45° field of view; 2352 x 1568 pixels; color fundus image — 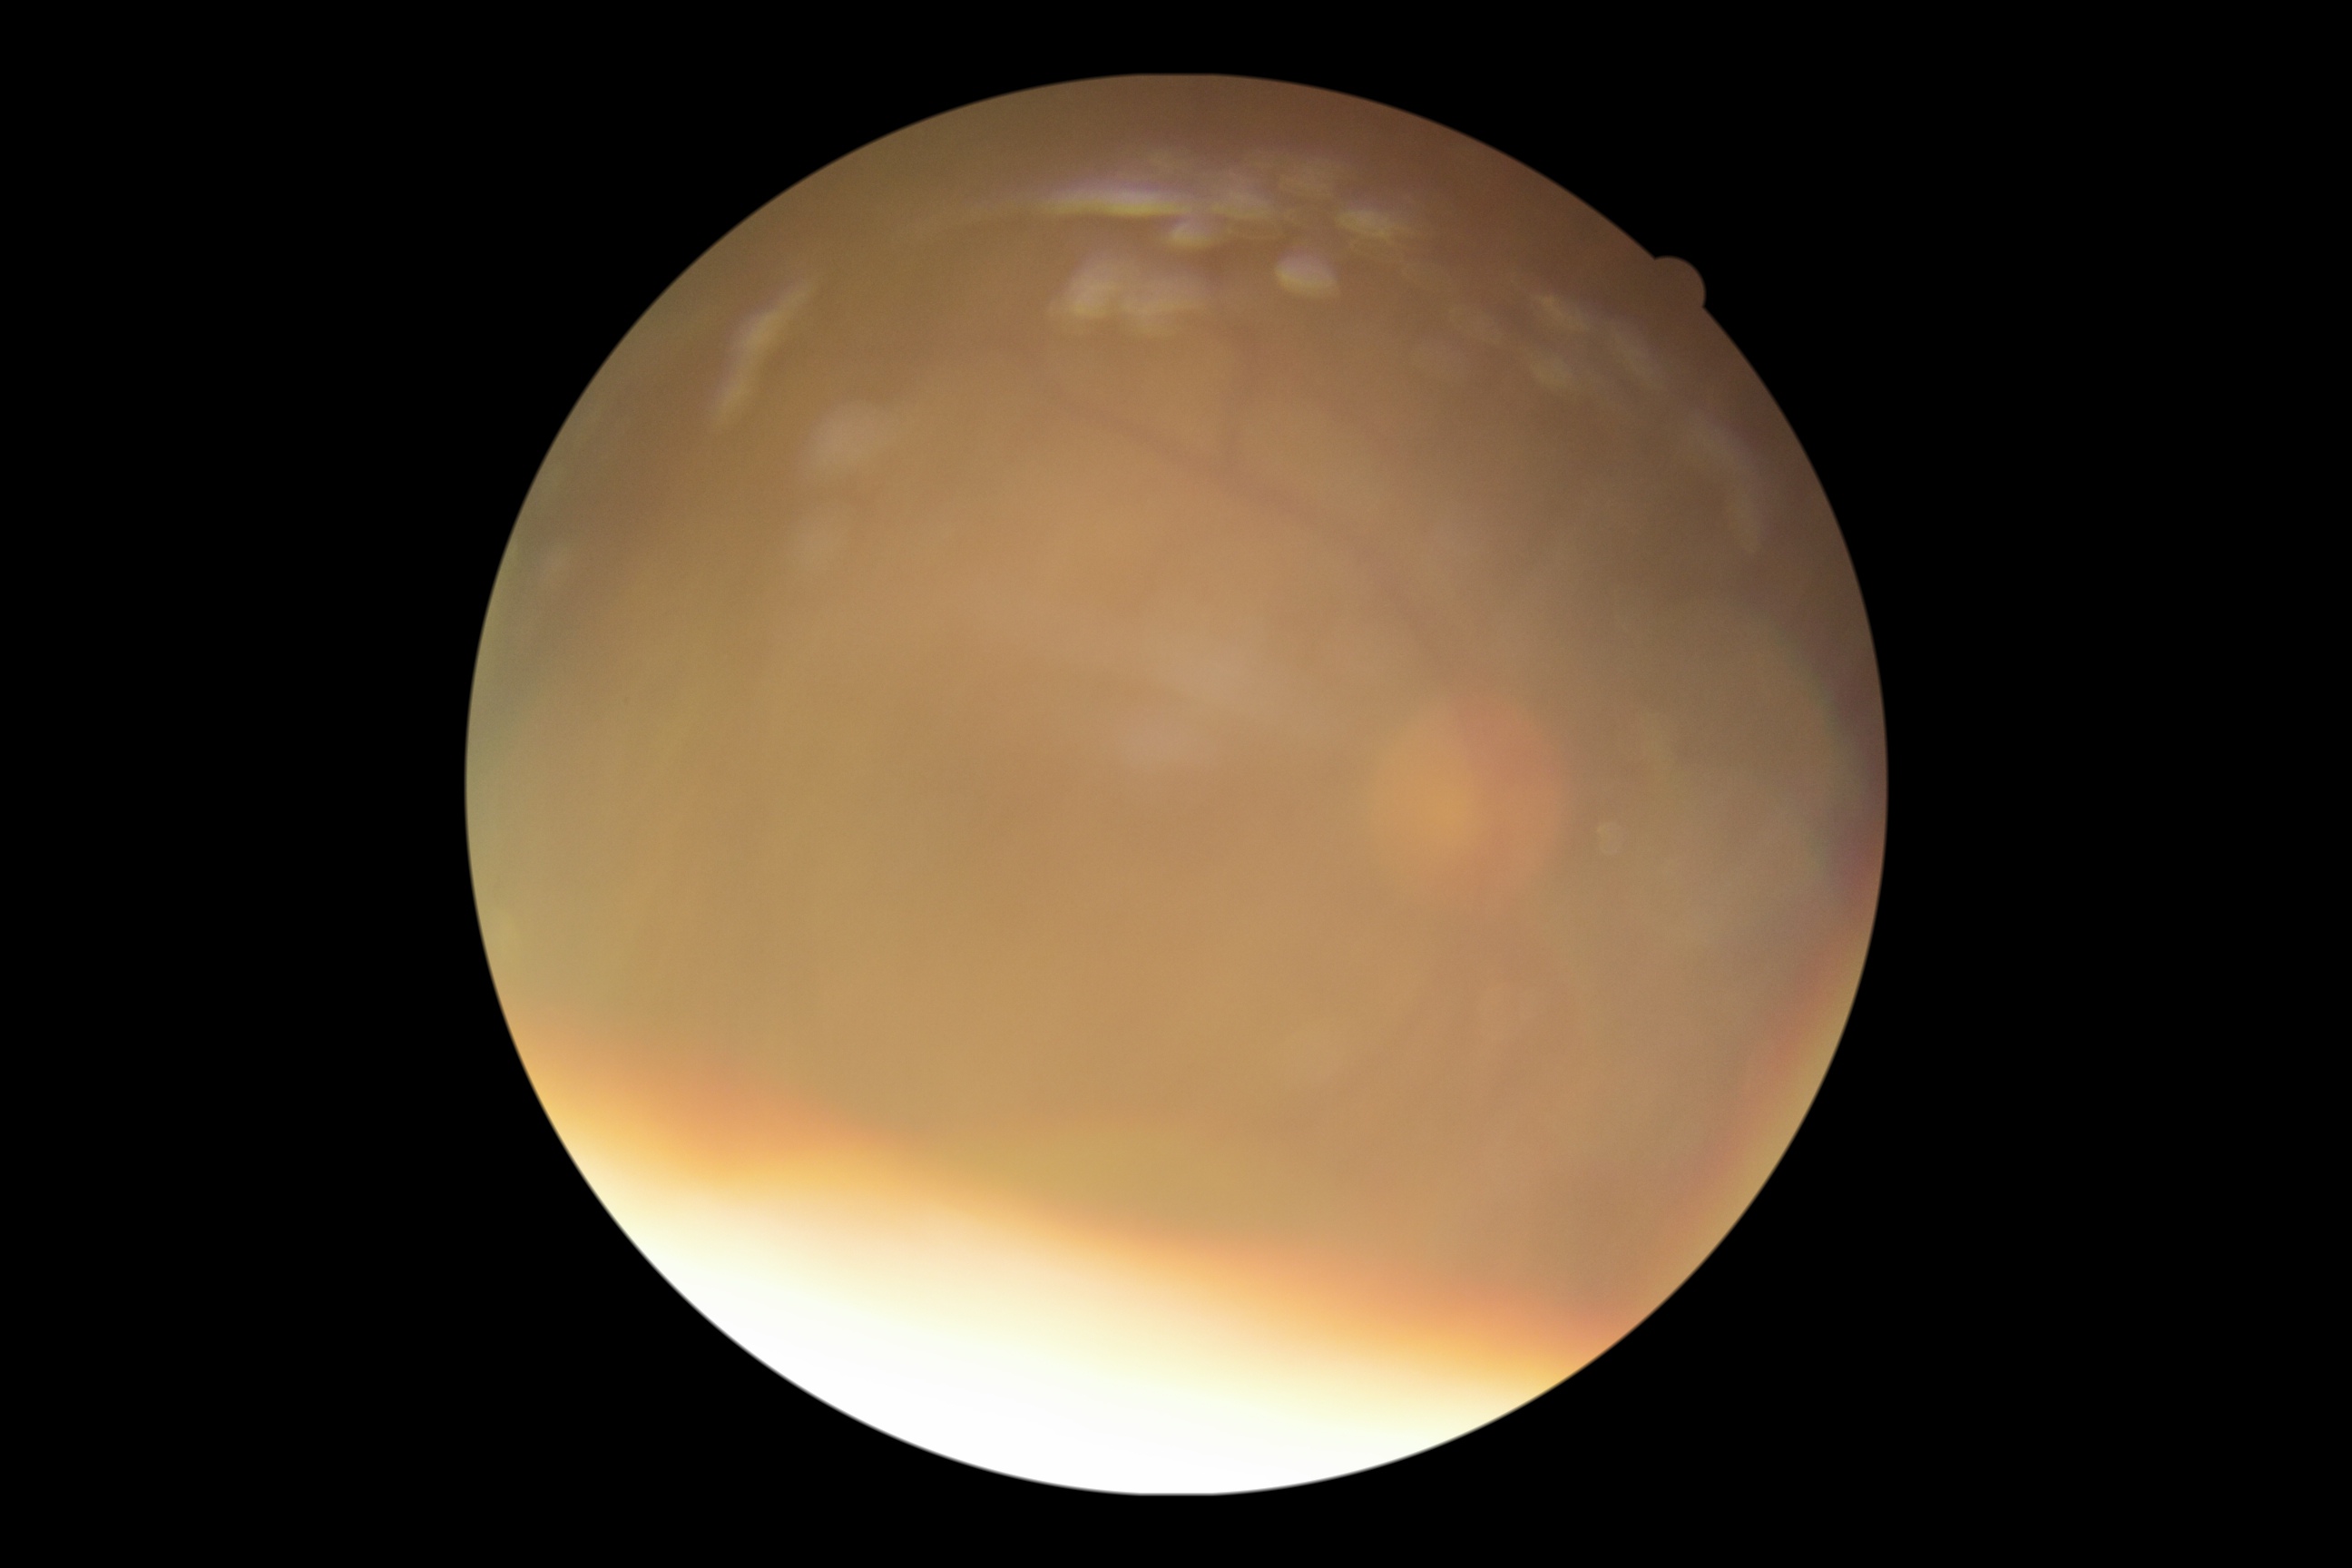 DR severity=ungradable due to poor image quality; image quality=insufficient.